Mydriatic (tropicamide and phenylephrine) · 2228x1652px
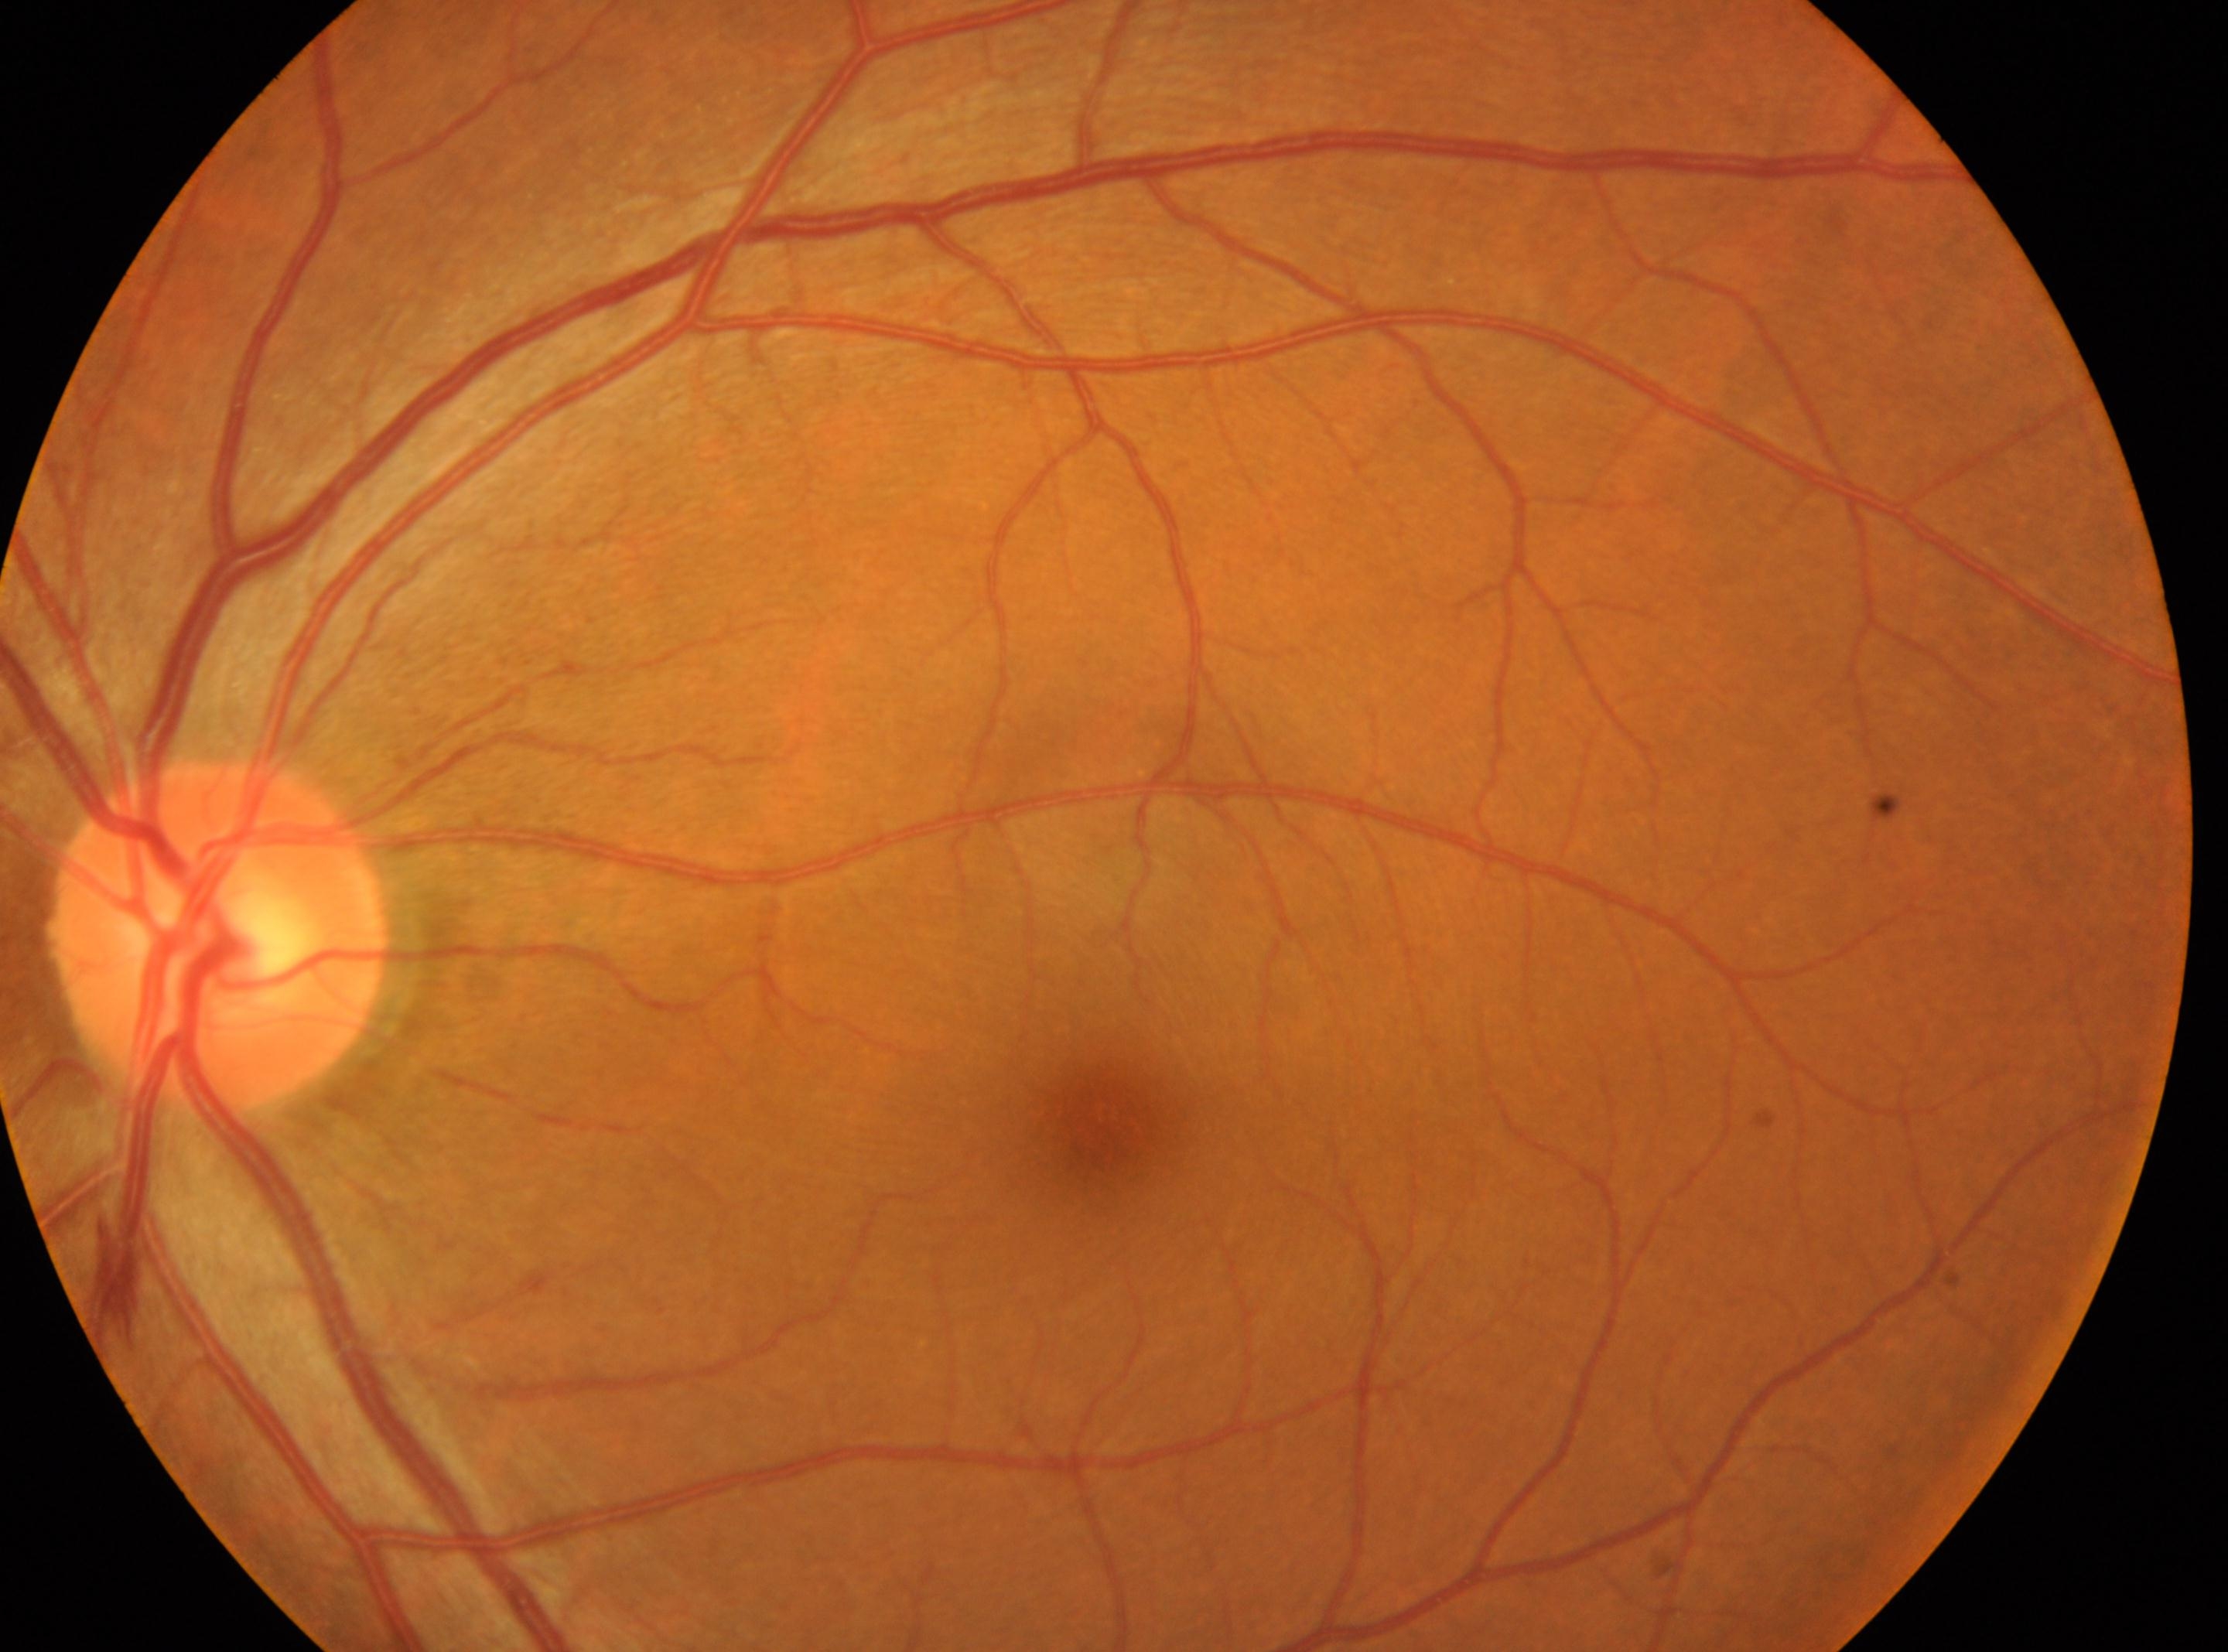

the optic disc = (215,938)
fovea centralis = (1105,1131)
laterality = left
diabetic retinopathy = 0